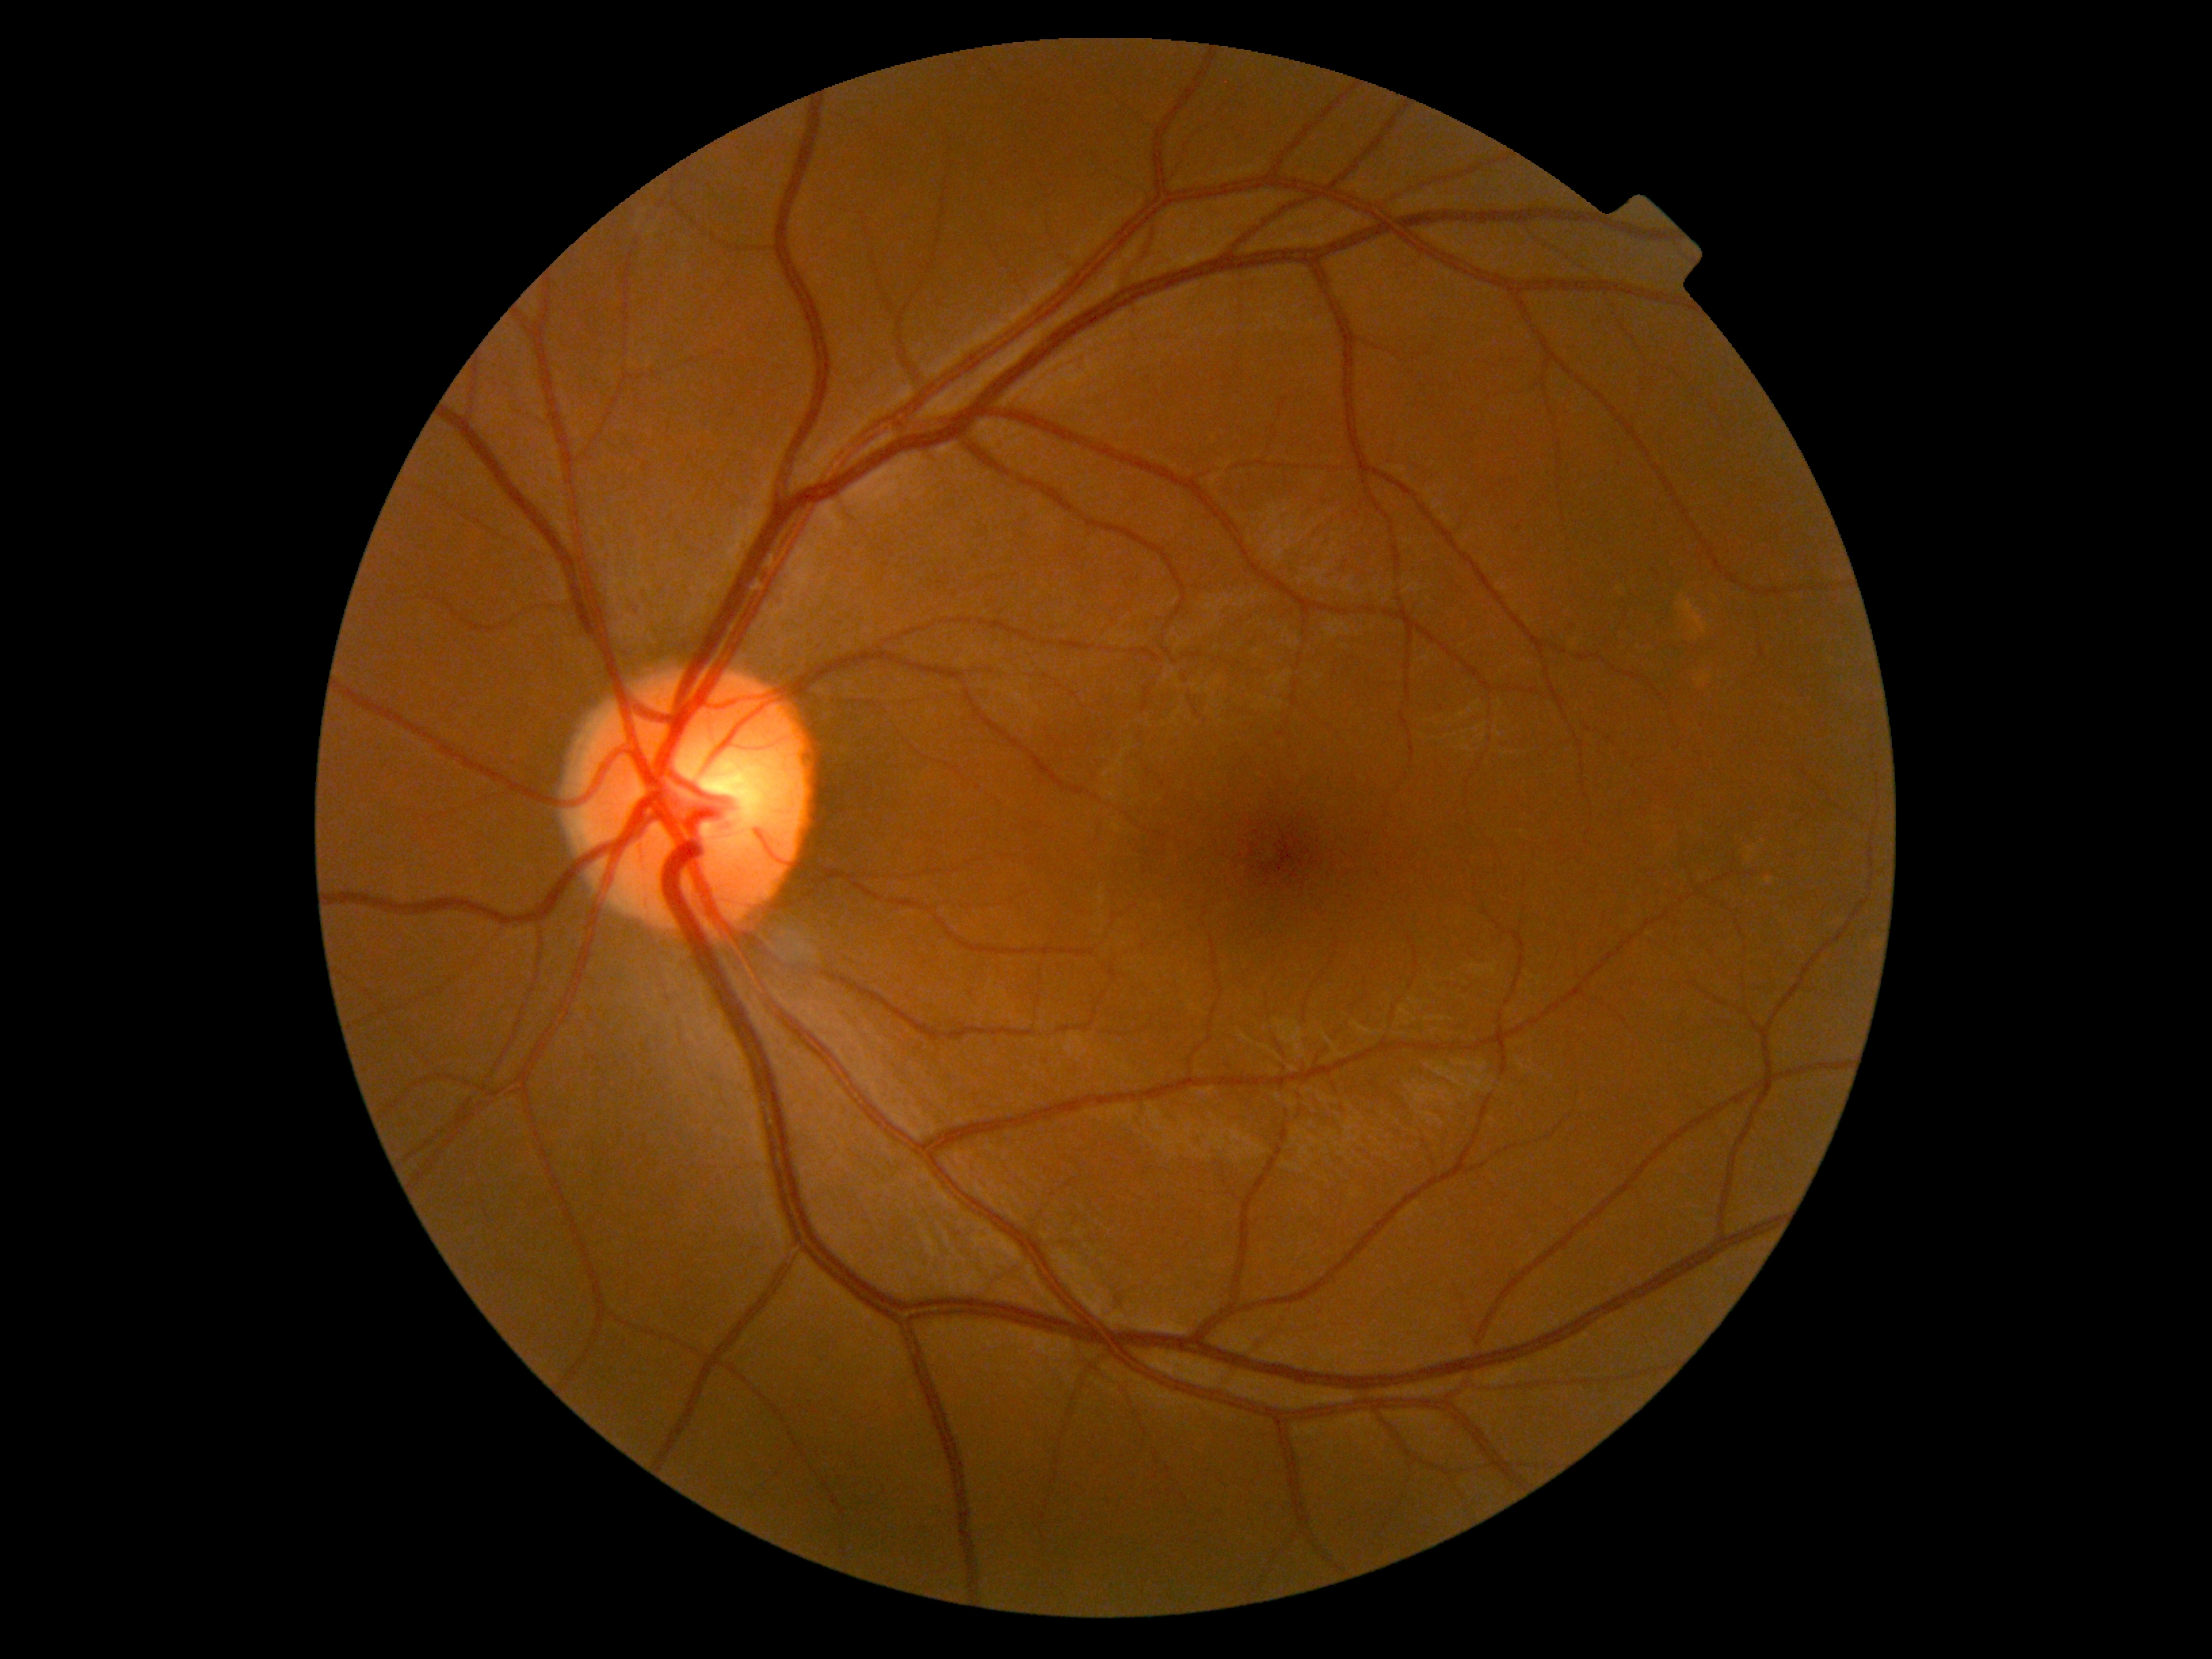
DR: 0
DR impression: no apparent DR